Retinal fundus photograph; 45° FOV; image size 1932x1916.
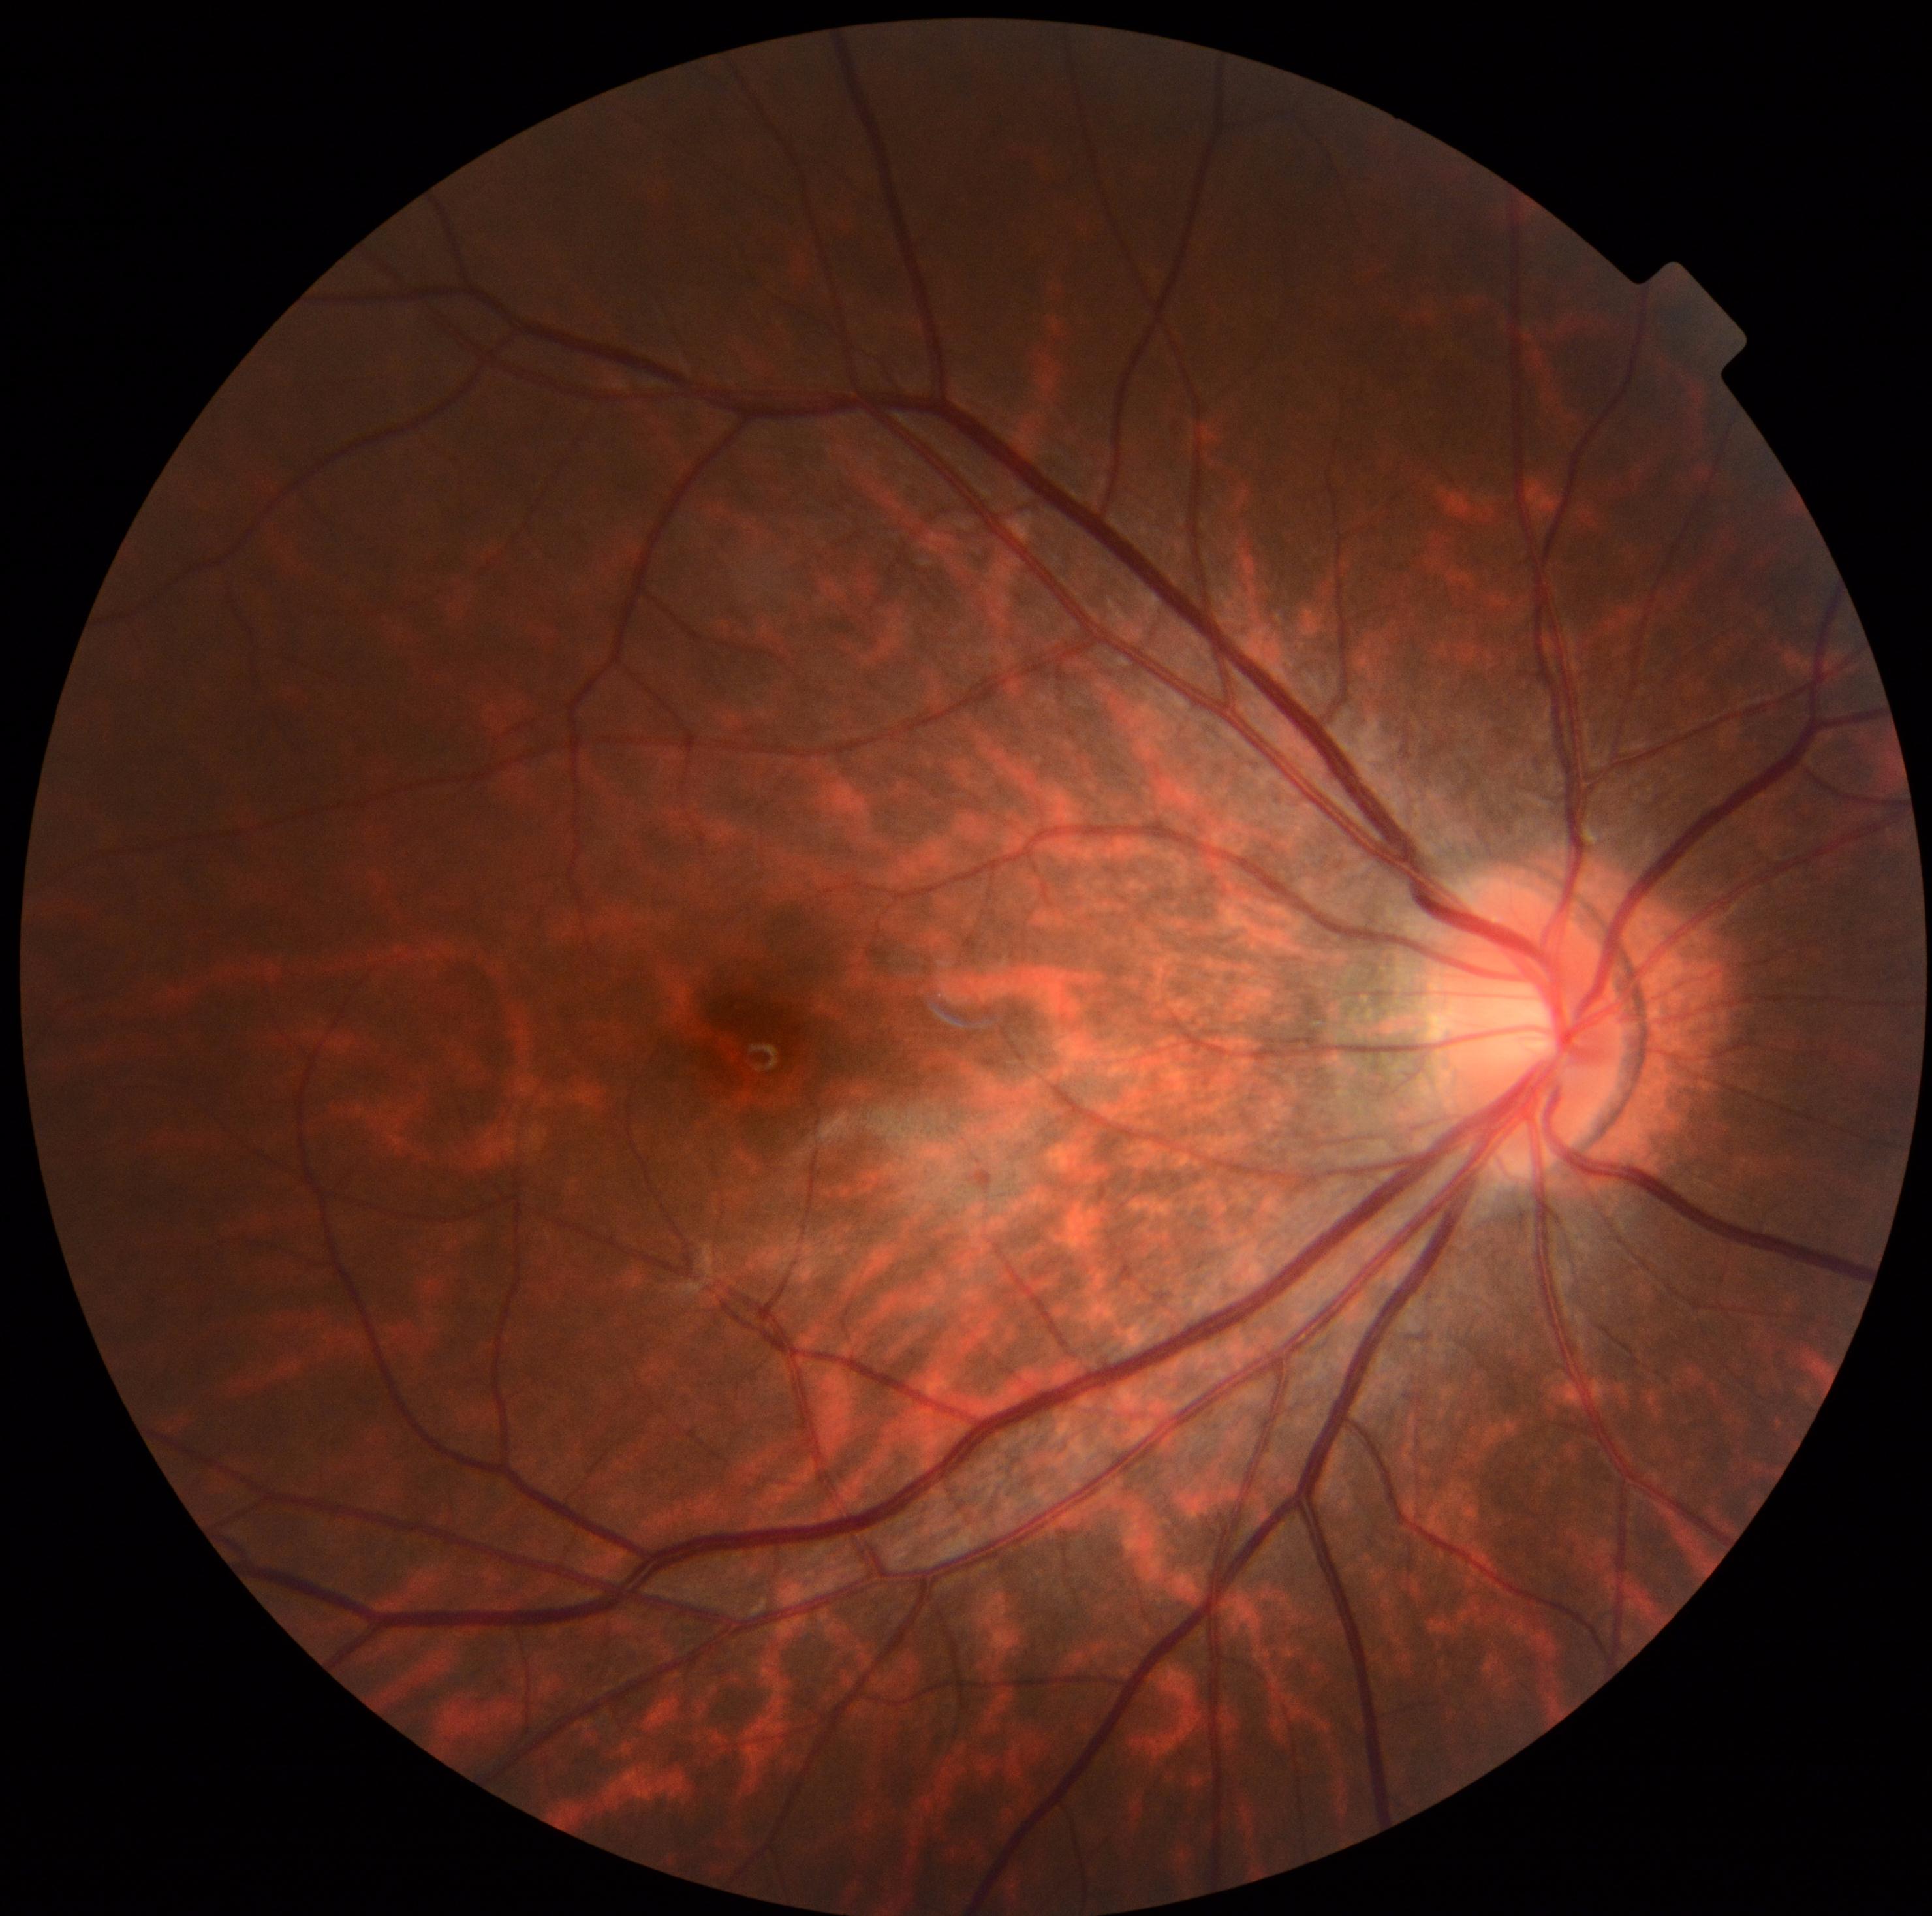
DR stage is no apparent retinopathy (grade 0) — no visible signs of diabetic retinopathy.